Pediatric retinal photograph (wide-field). Acquired on the Phoenix ICON:
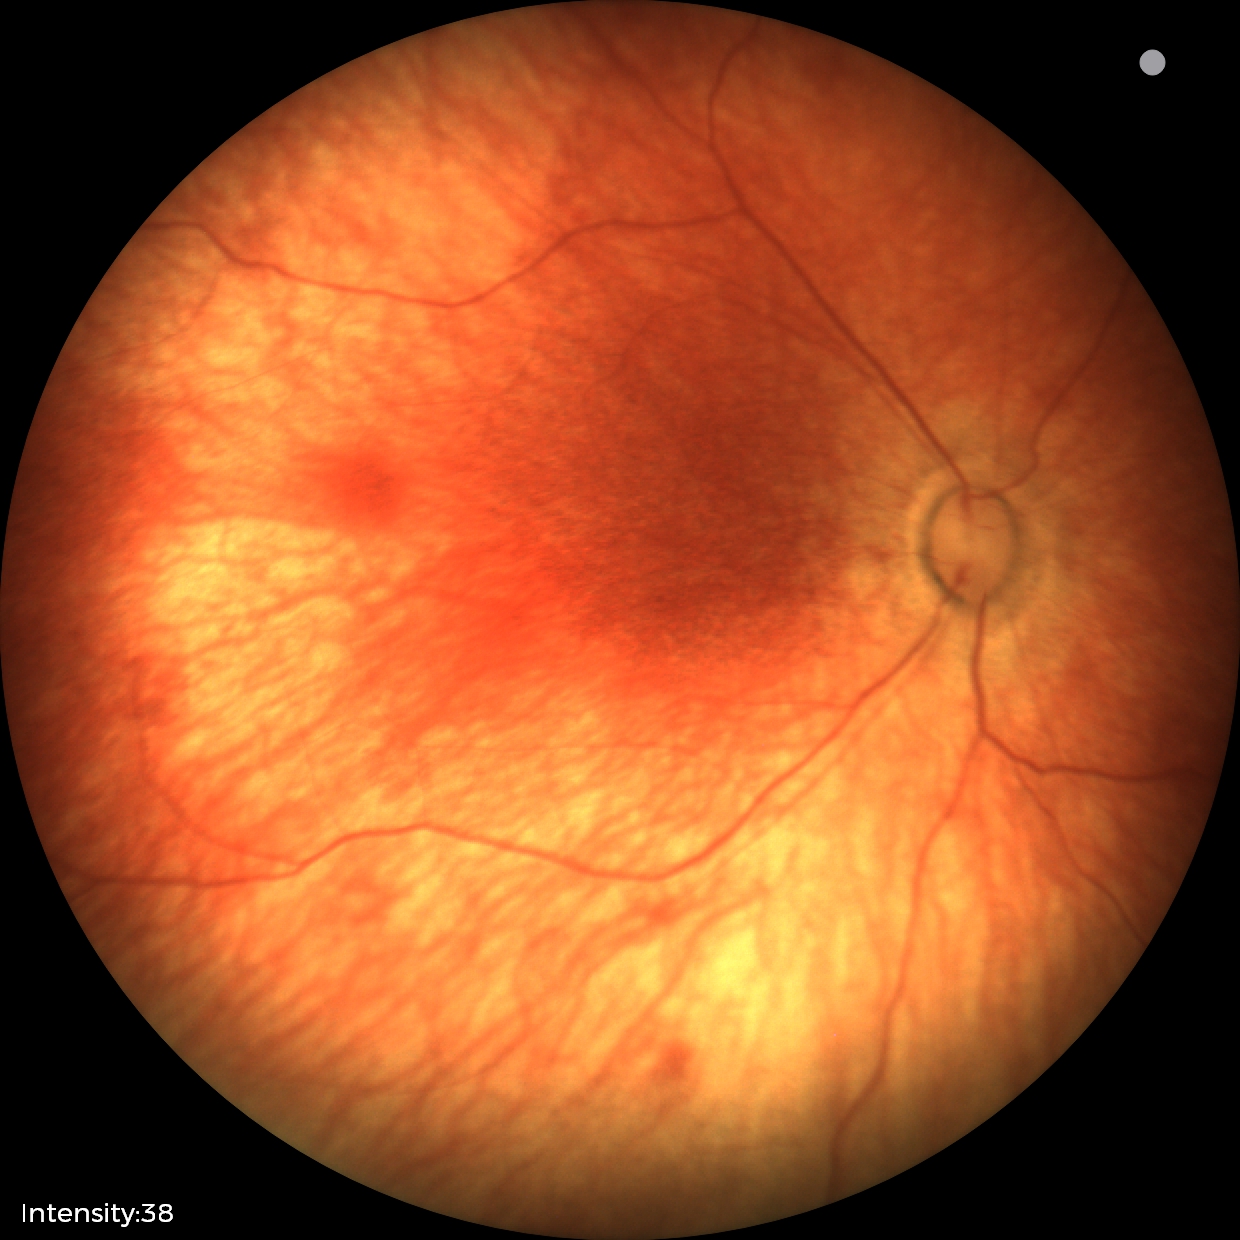 Screening: no abnormal retinal findings.